Camera: Topcon TRC-50DX; captured after pupil dilation
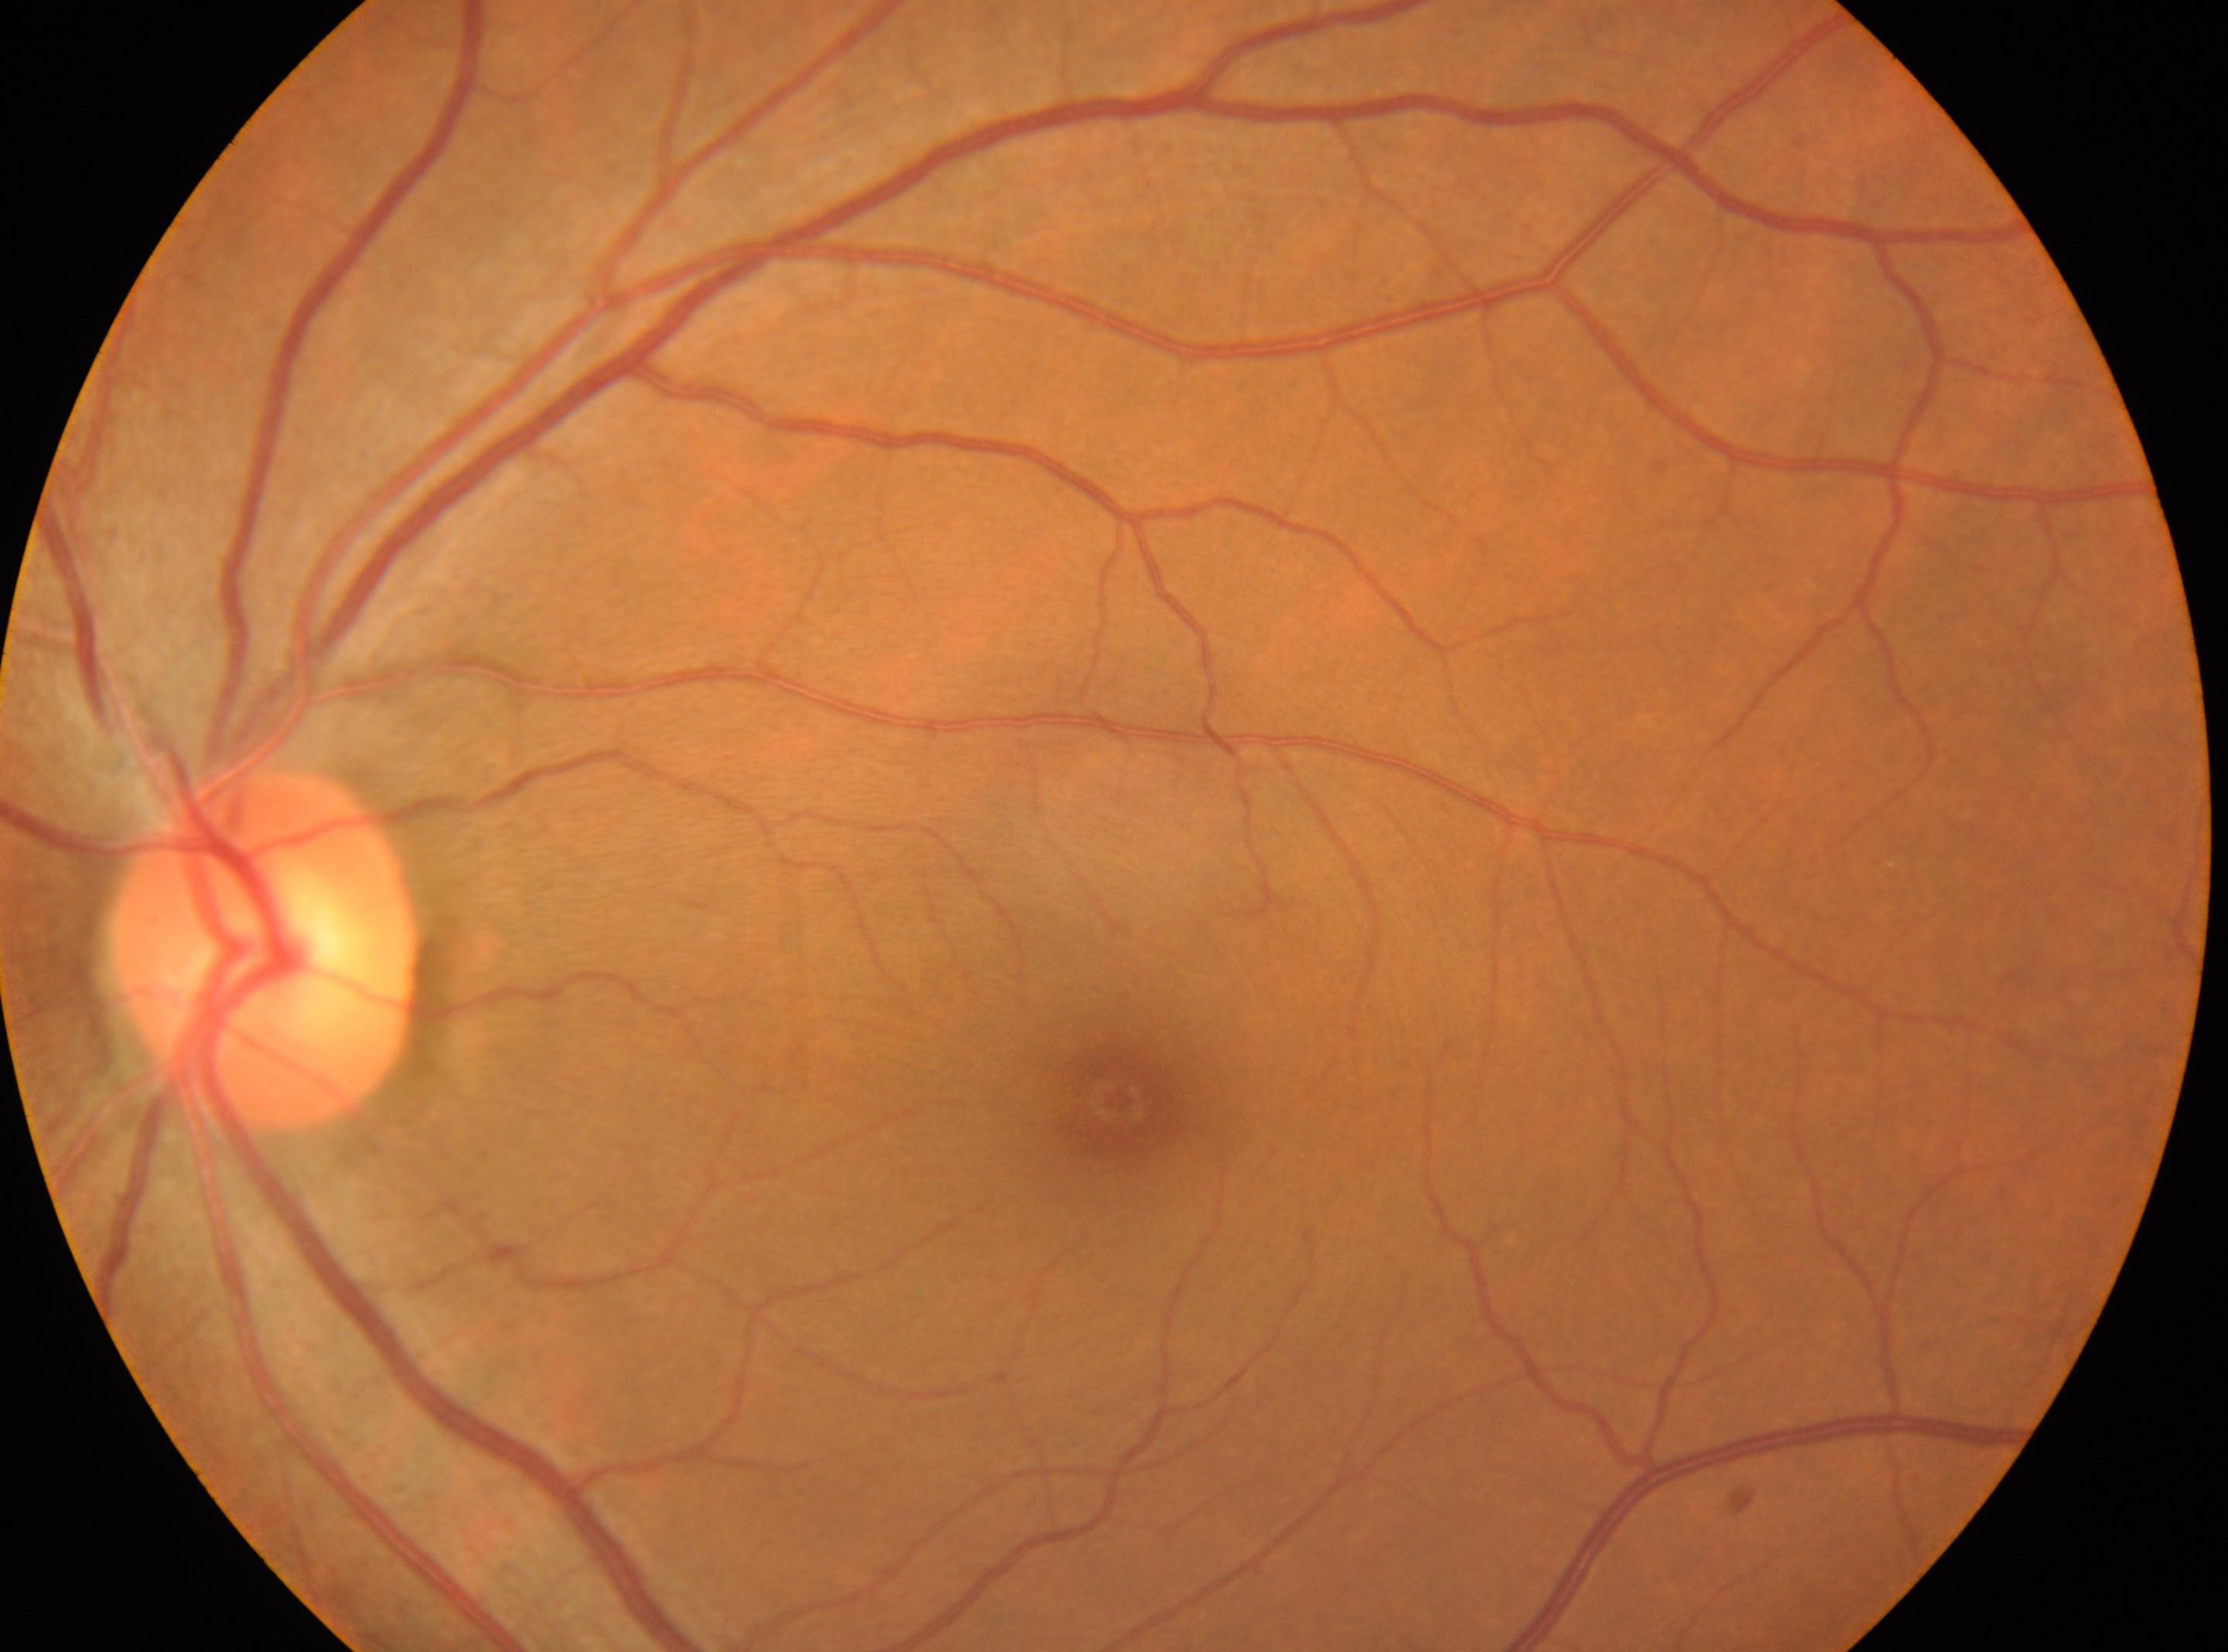

Diabetic retinopathy (DR): no apparent retinopathy (grade 0). No DR findings. The optic nerve head is at 265, 951. Foveal center: 1116, 1098. The image shows the left eye.